Retinal fundus photograph. 45° FOV — 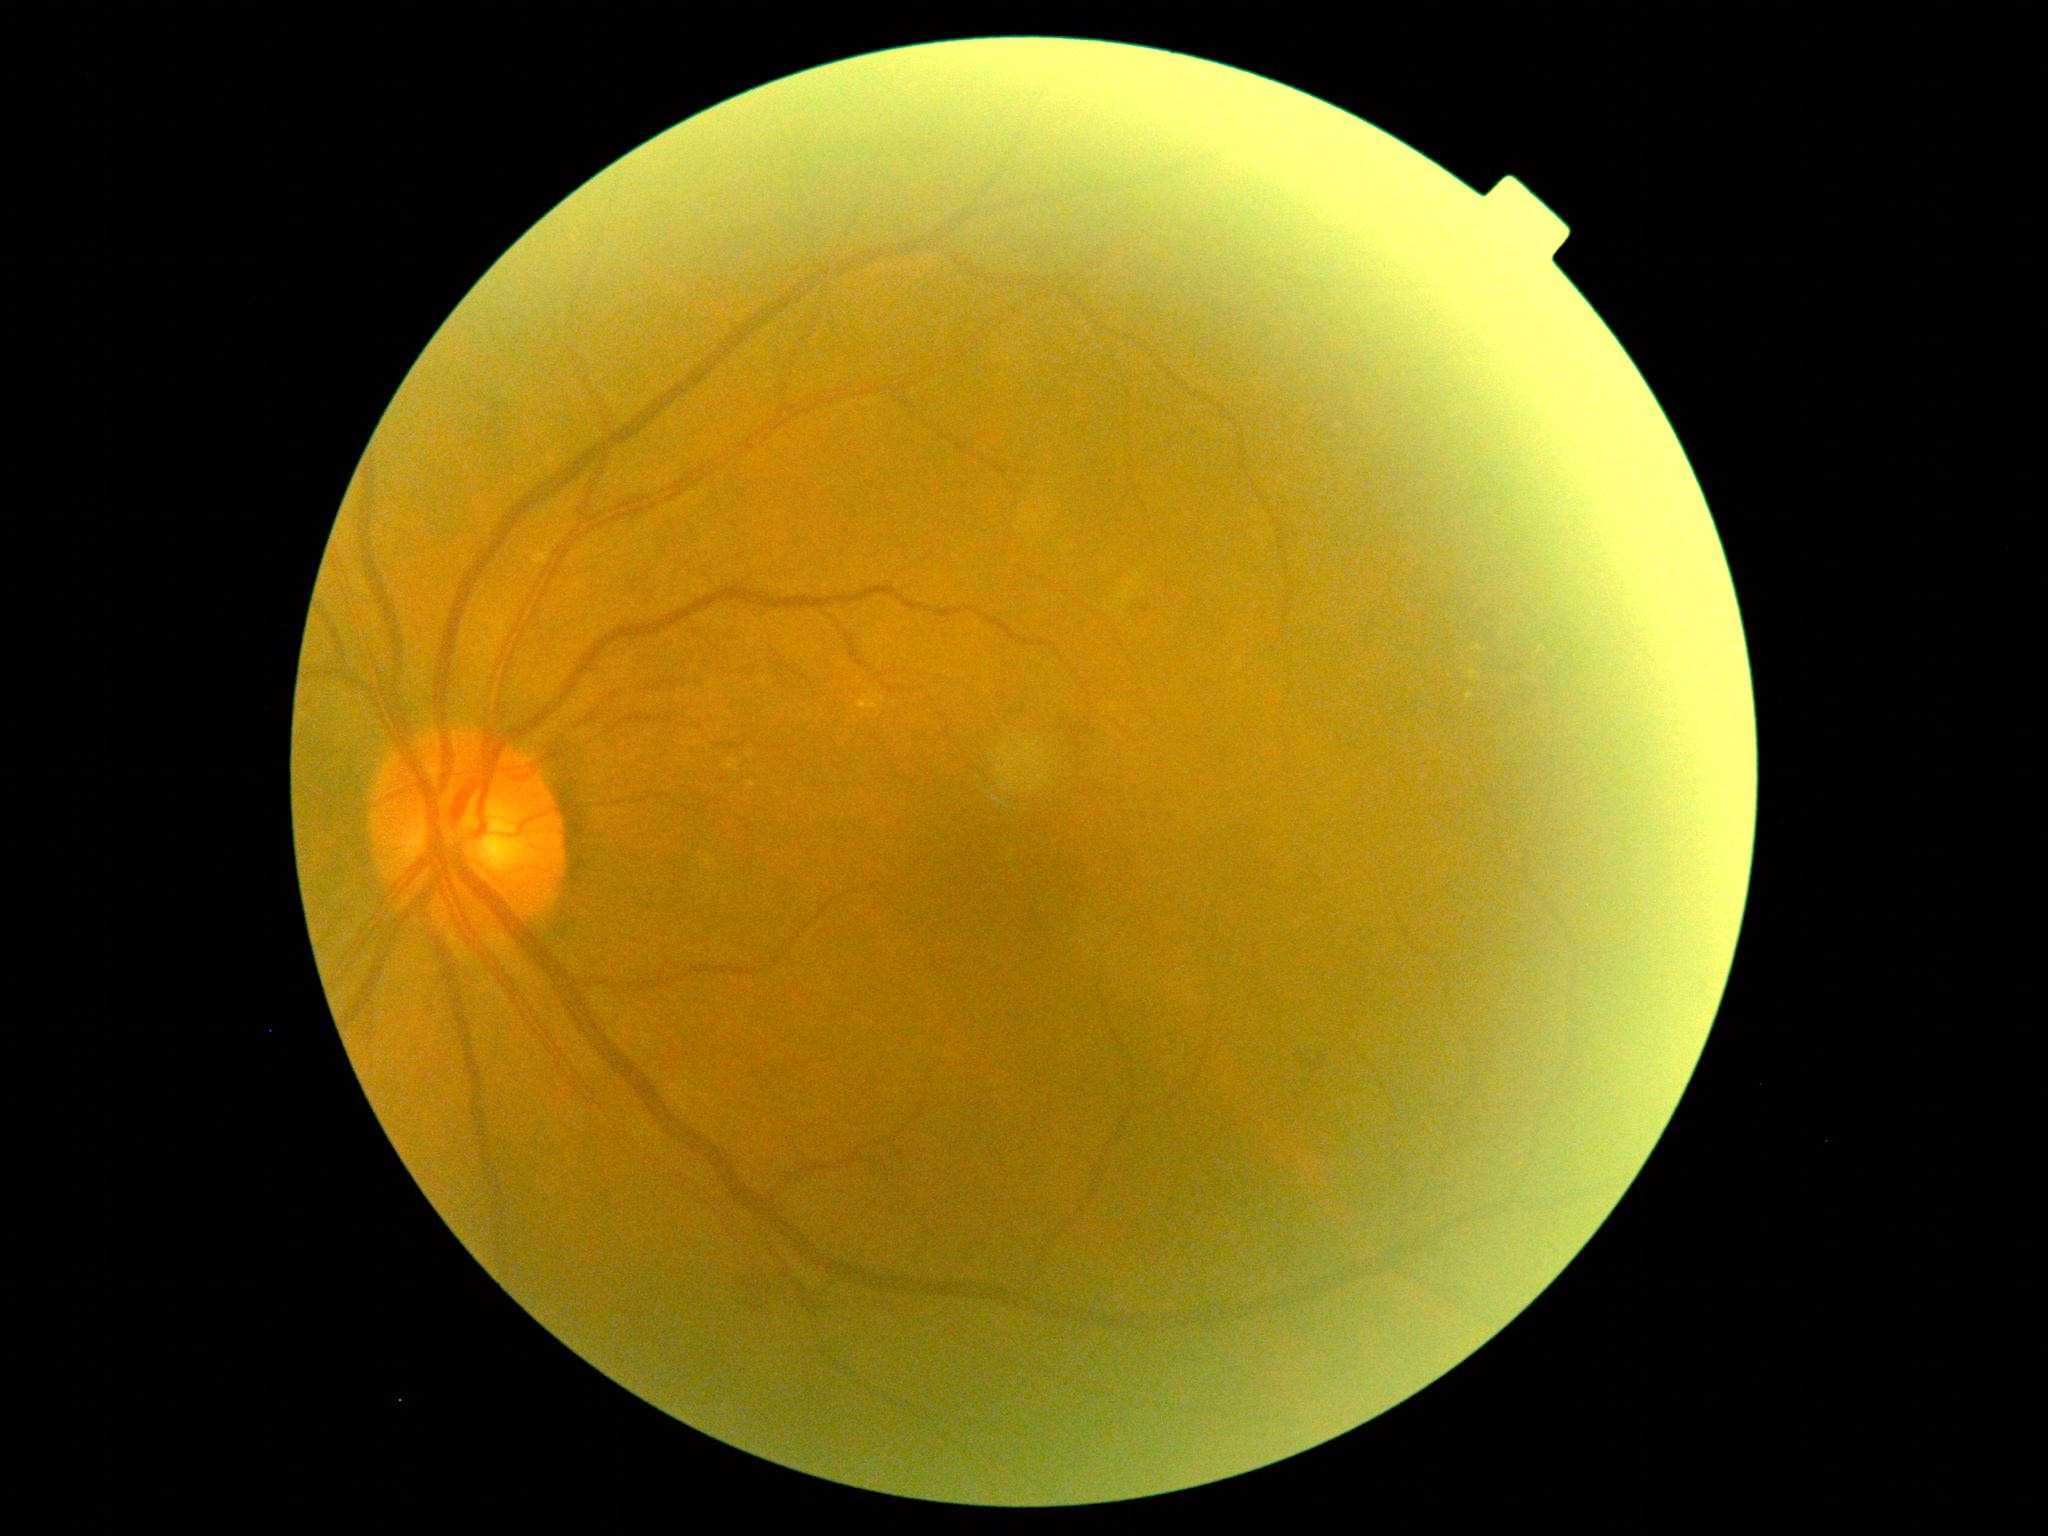
Findings:
– DR — 2